130° field of view (Natus RetCam Envision) · image size 1440x1080 · infant wide-field fundus photograph:
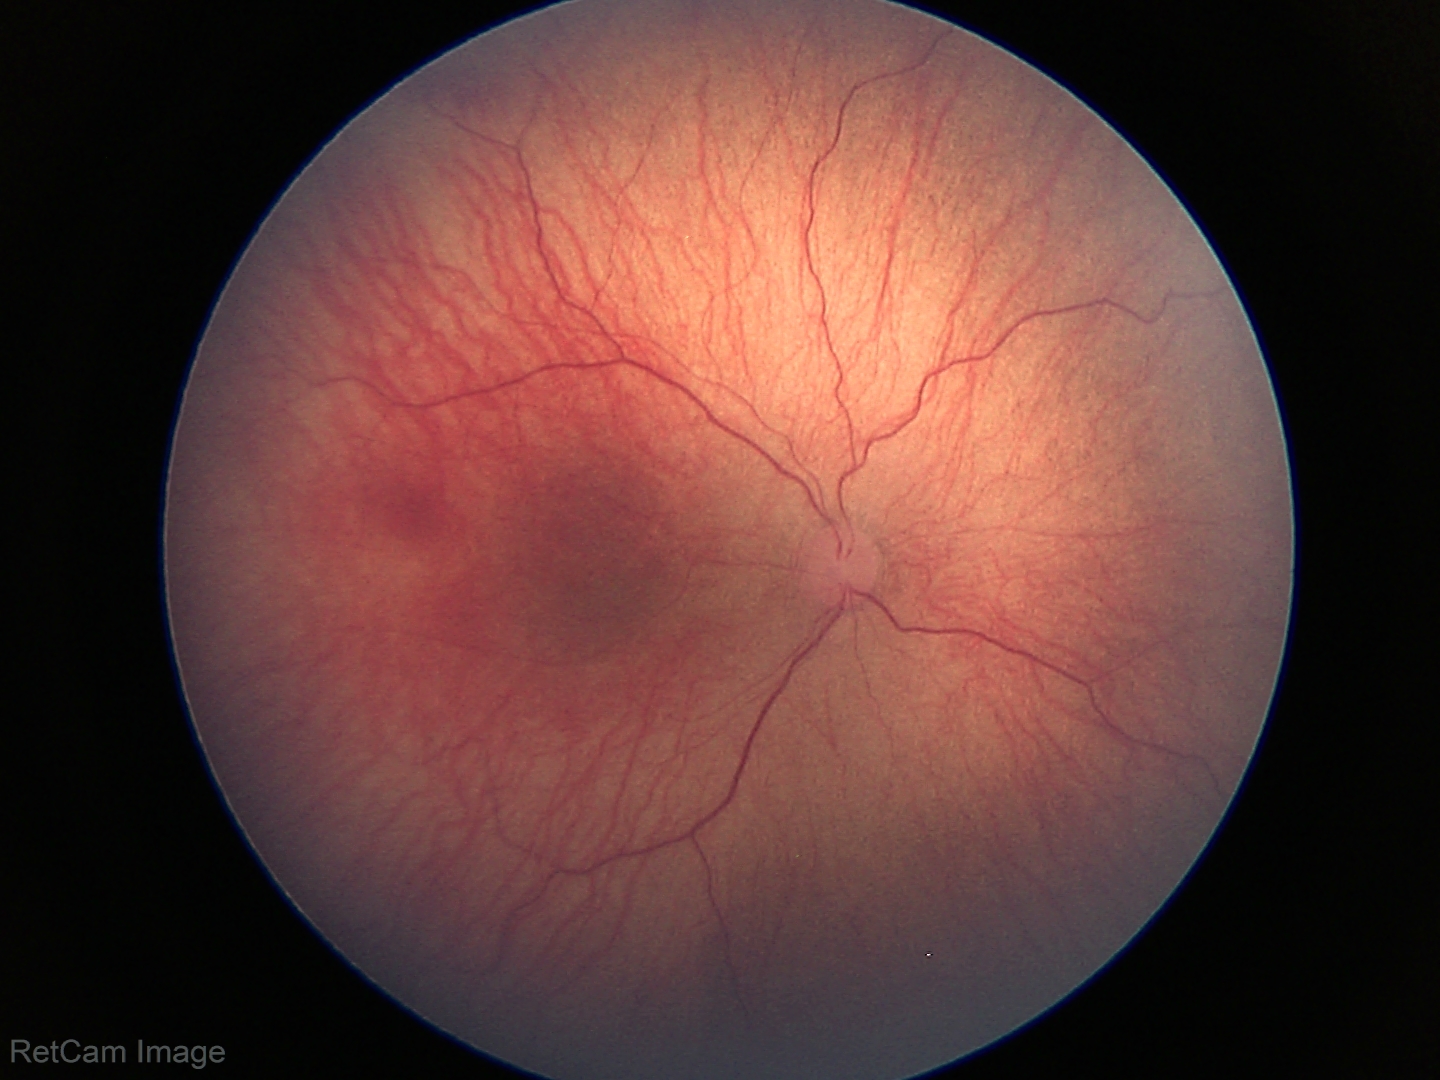

Diagnosis from this screening exam: retinopathy of prematurity stage 1.